1240 by 1240 pixels; wide-field fundus photograph of an infant
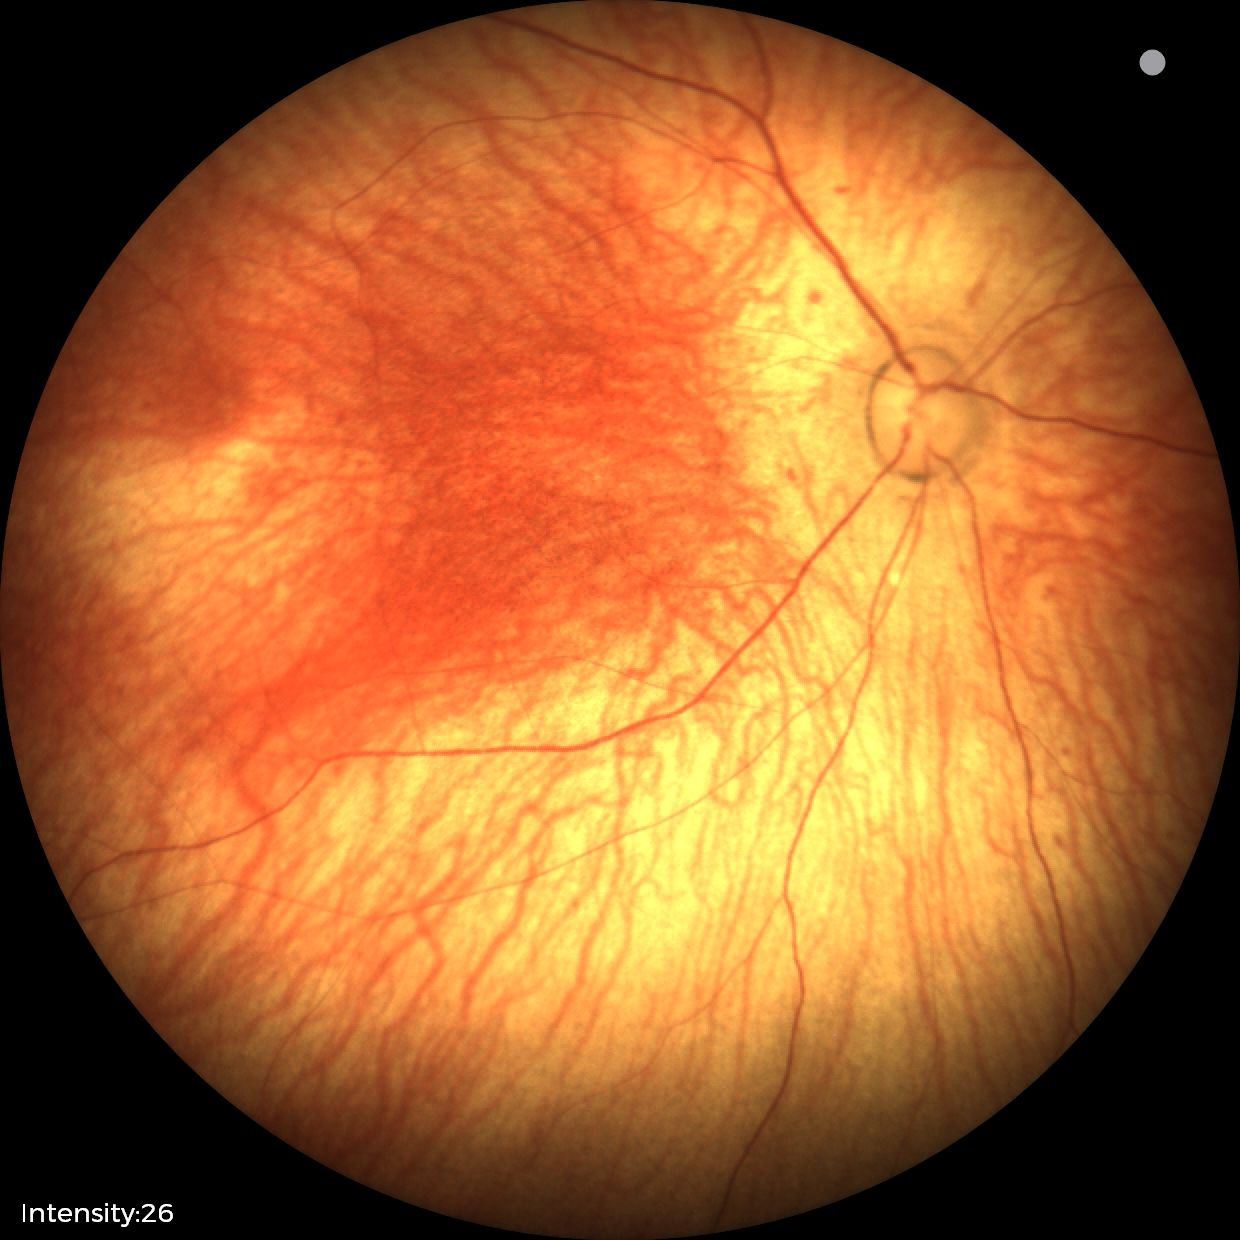

Normal screening examination.